Macula-centered:
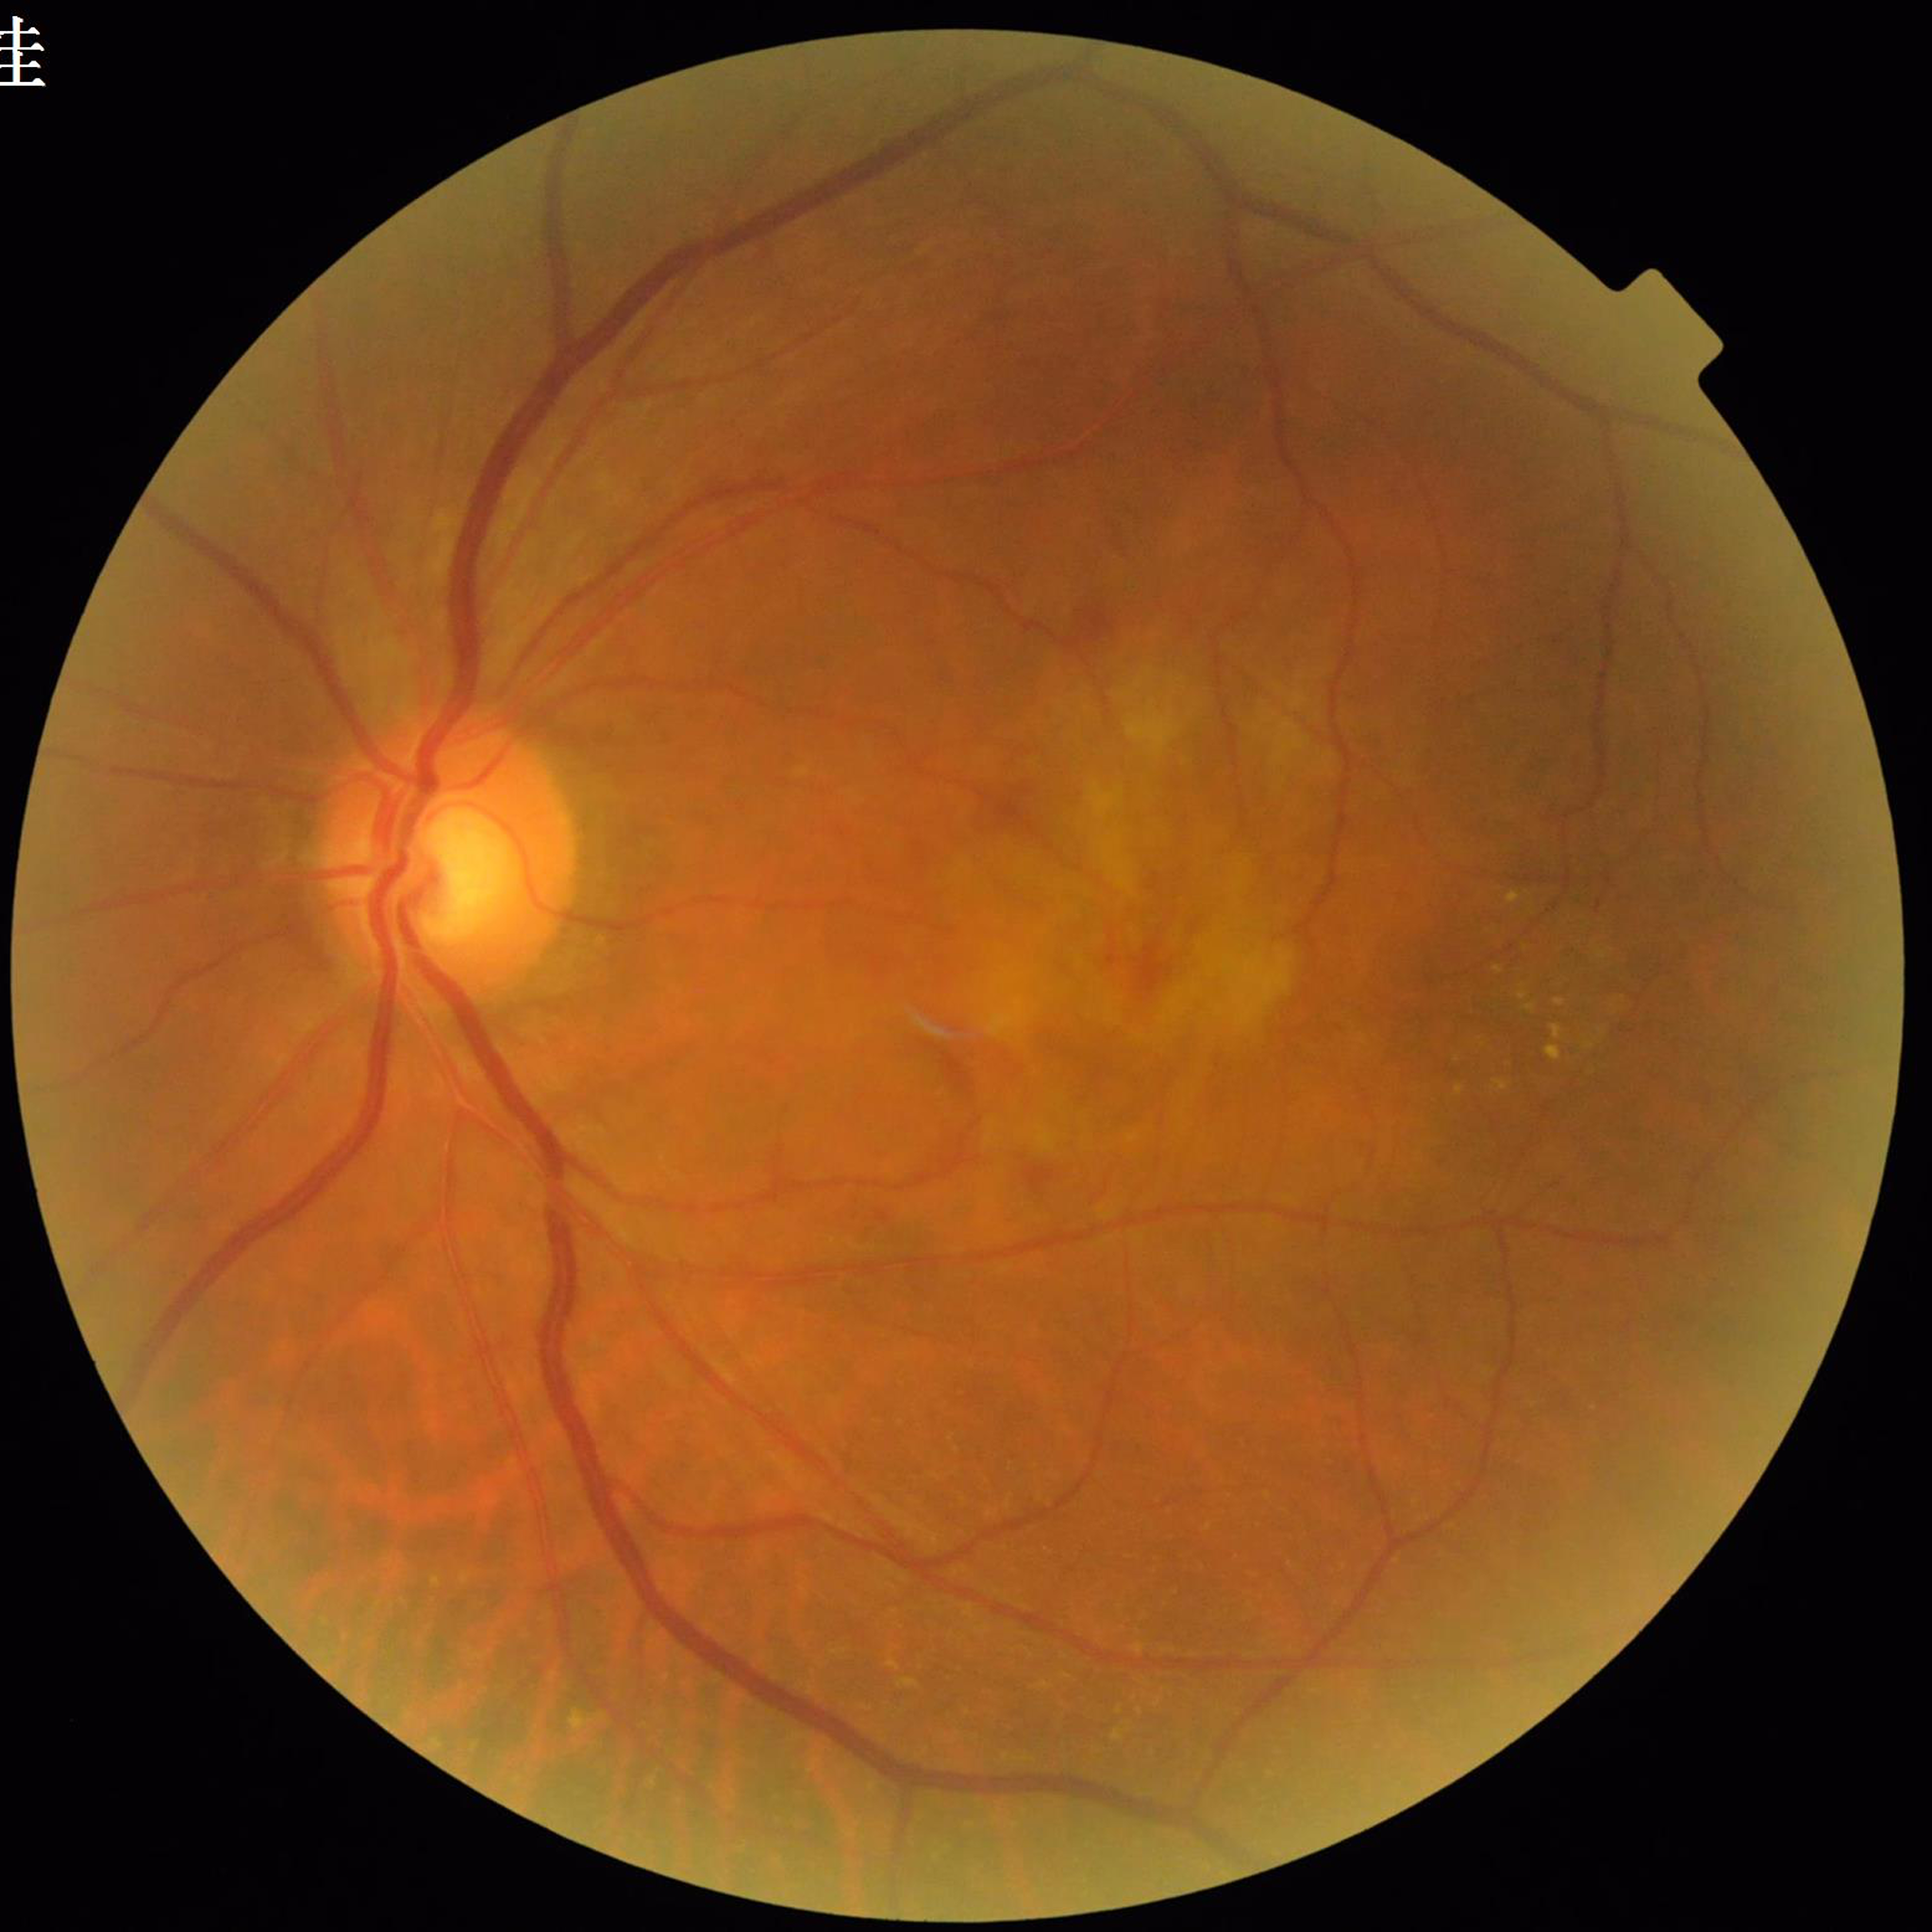
Color fundus photo. Patient diagnosed with age-related macular degeneration.
Quality: satisfactory.